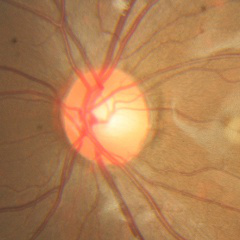 Optic disc appearance consistent with no evidence of glaucoma.